Mydriatic (tropicamide phenylephrine 1.0%), 50° FOV — 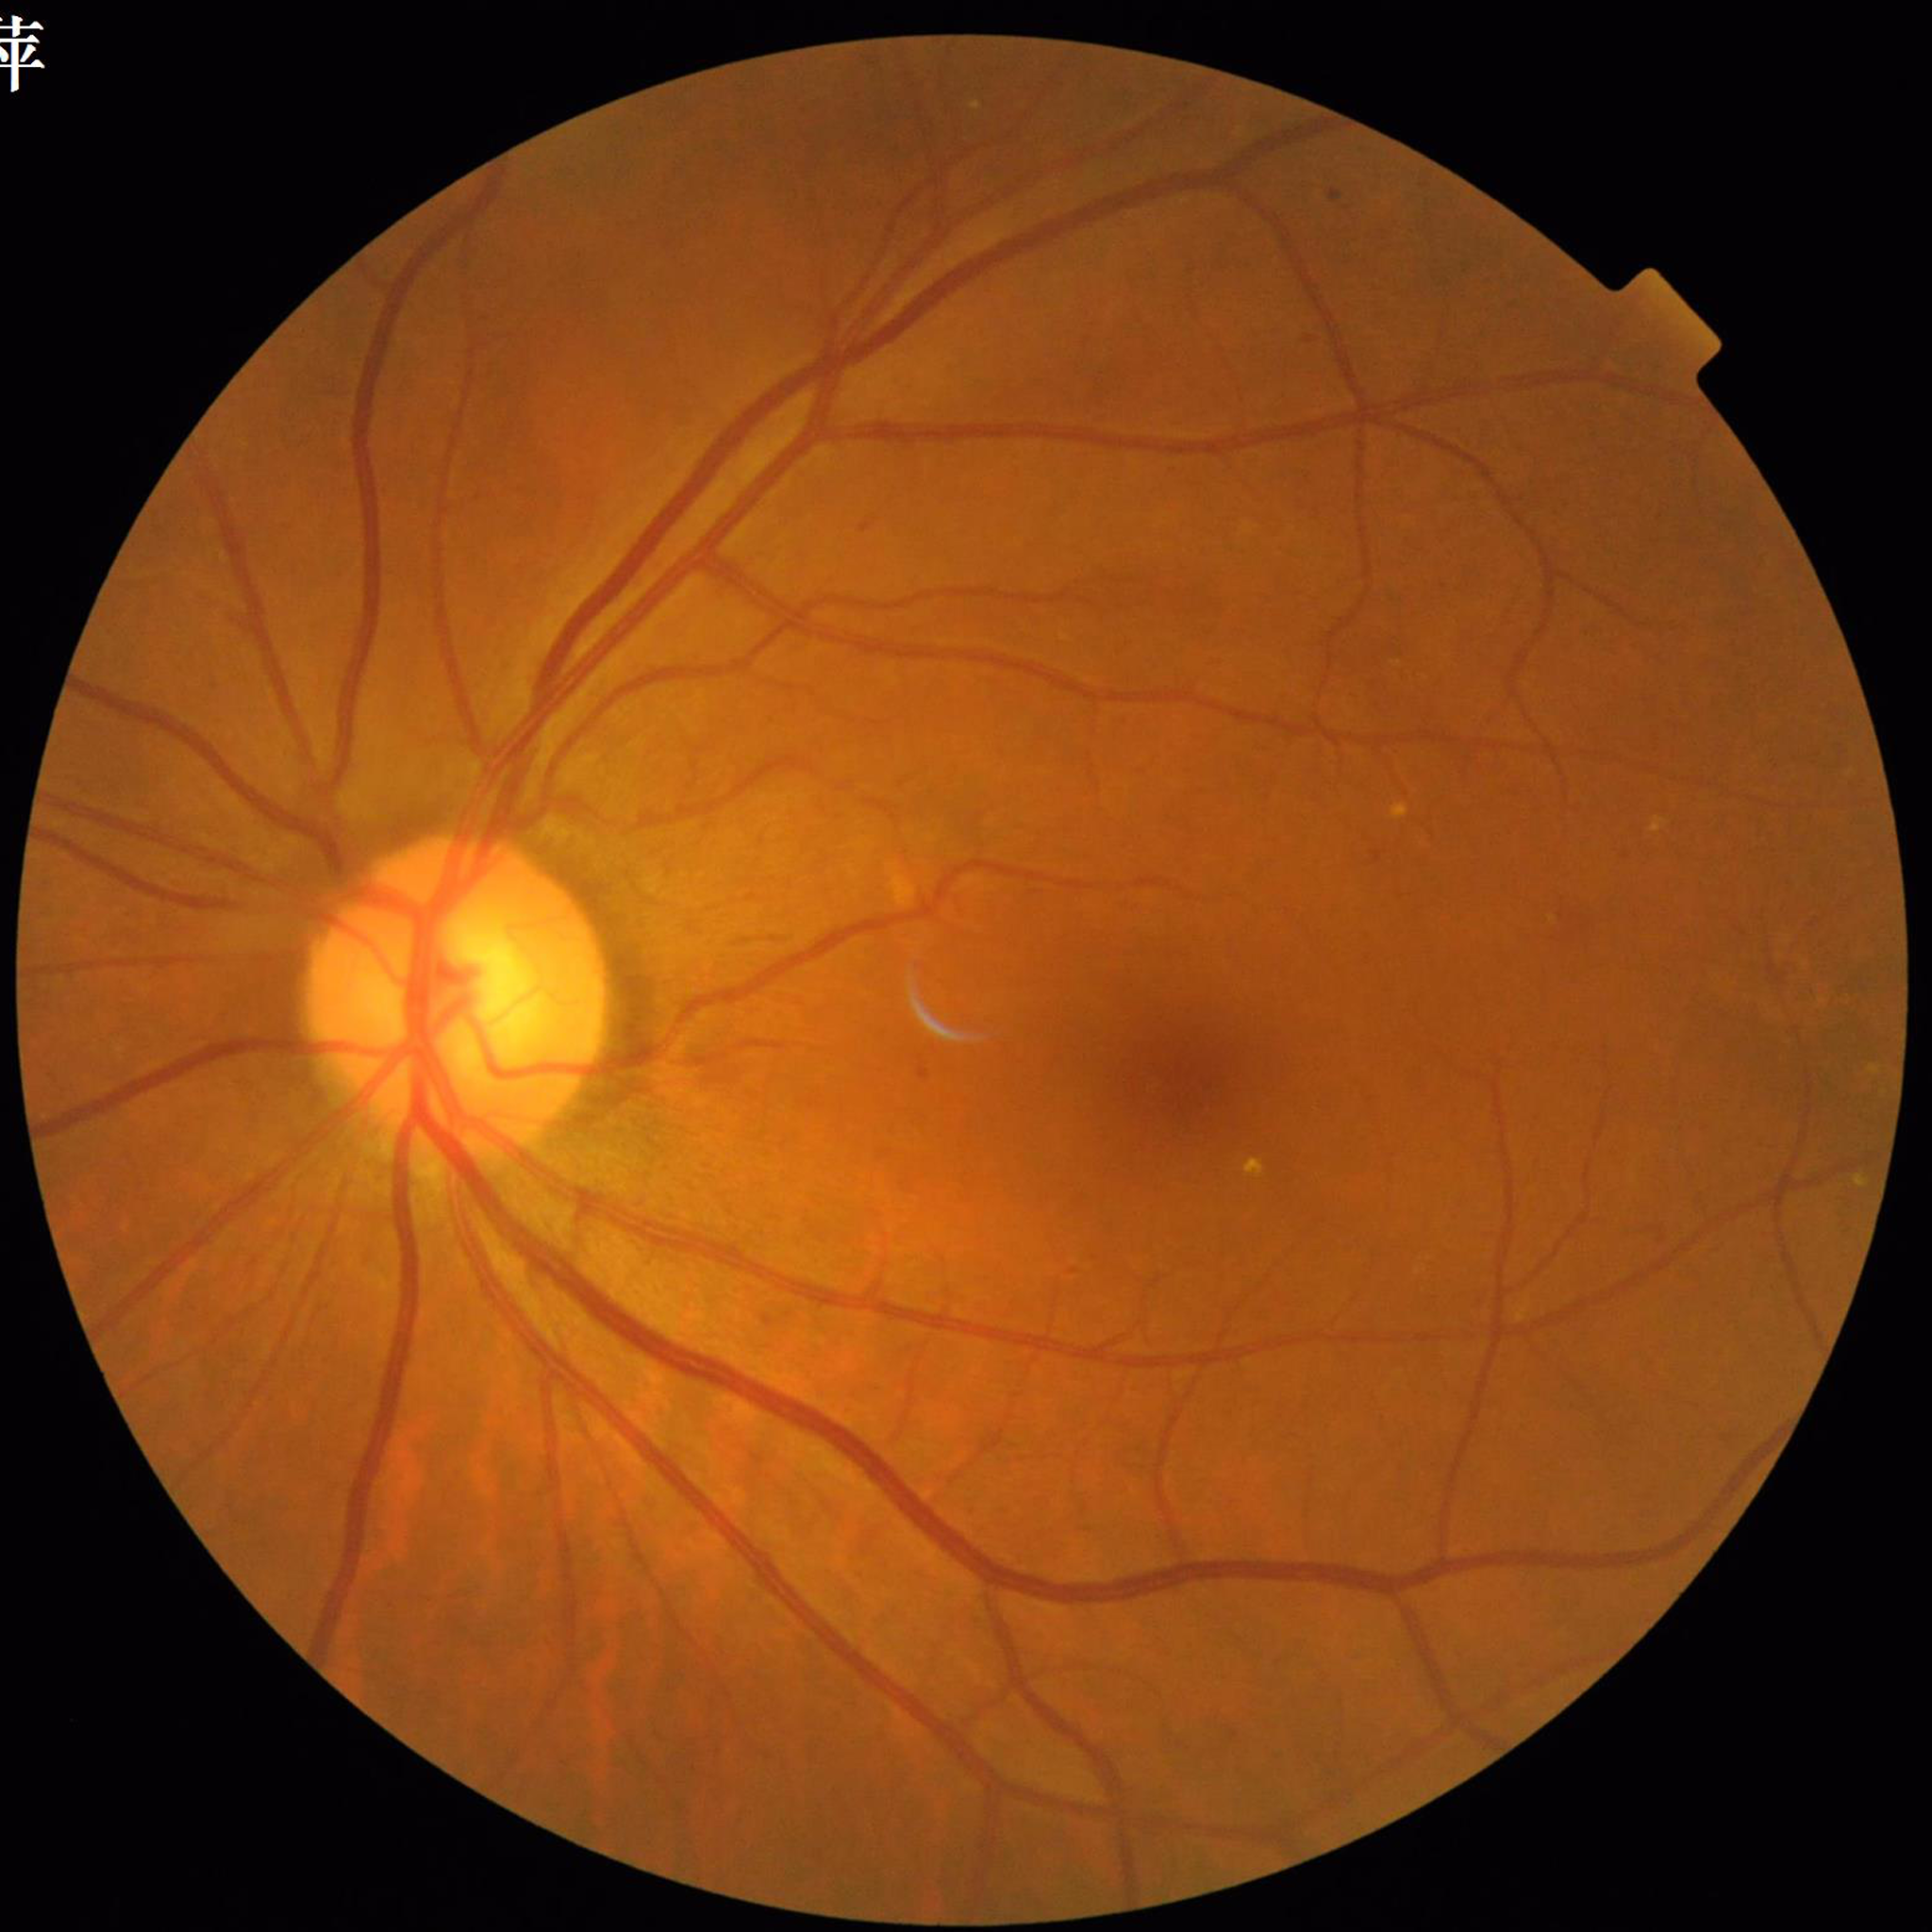

Eye affected by diabetic retinopathy.